Wide-field contact fundus photograph of an infant — 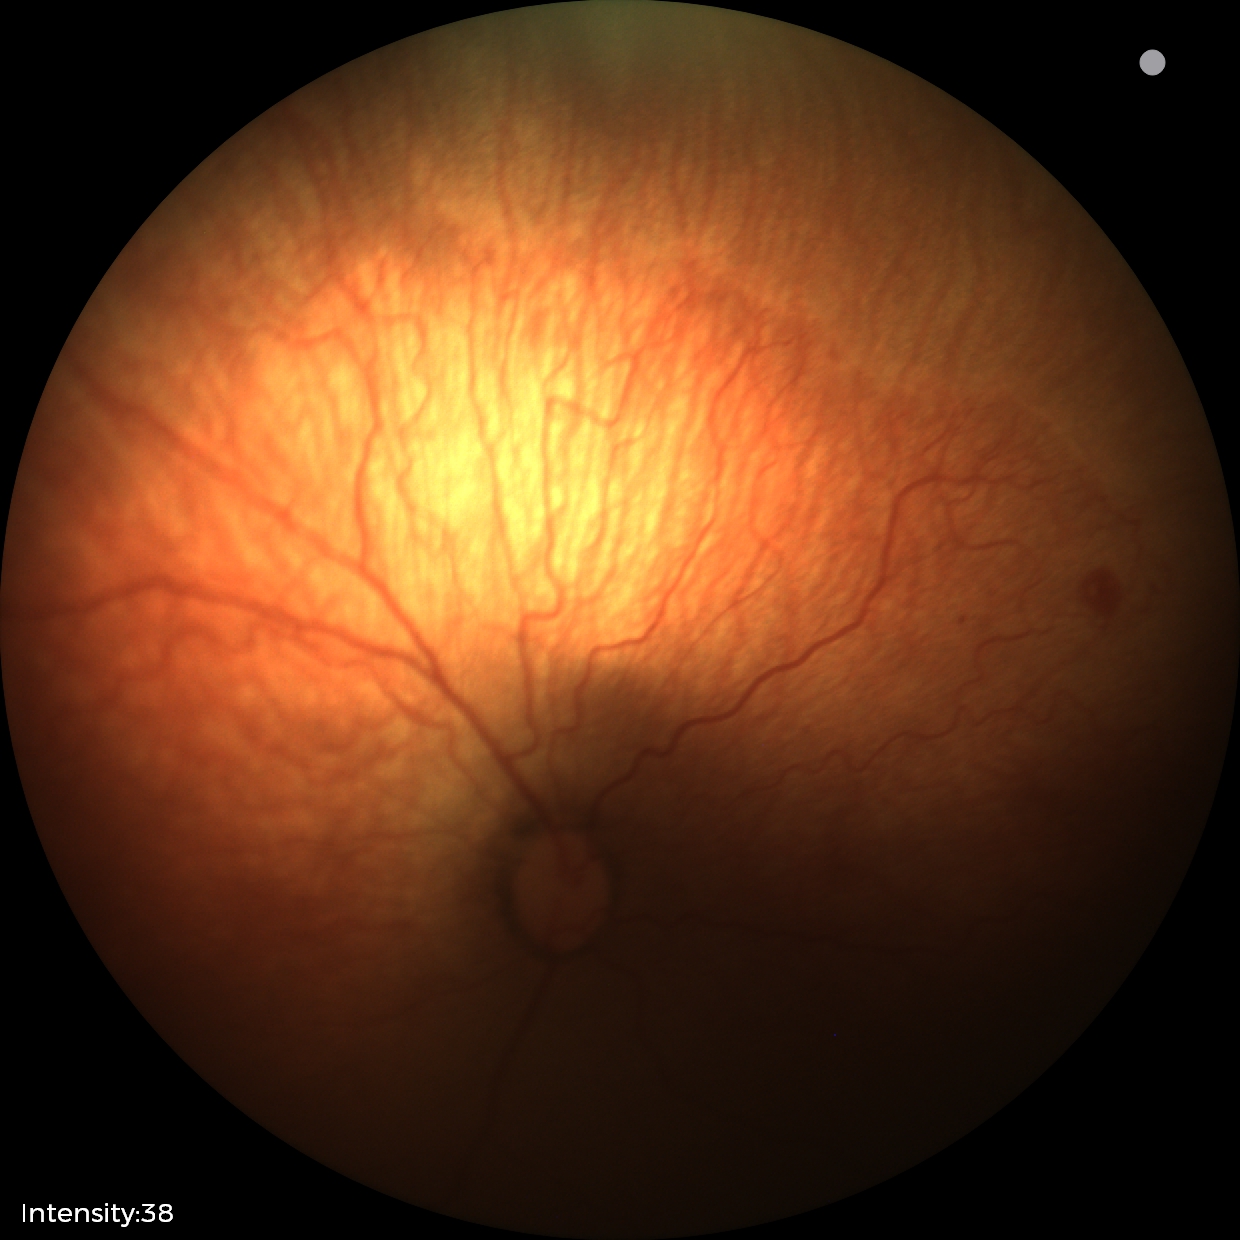
No plus disease.
Screening examination consistent with retinopathy of prematurity (ROP) stage 1.